Retinal fundus photograph; 1932x1916px — 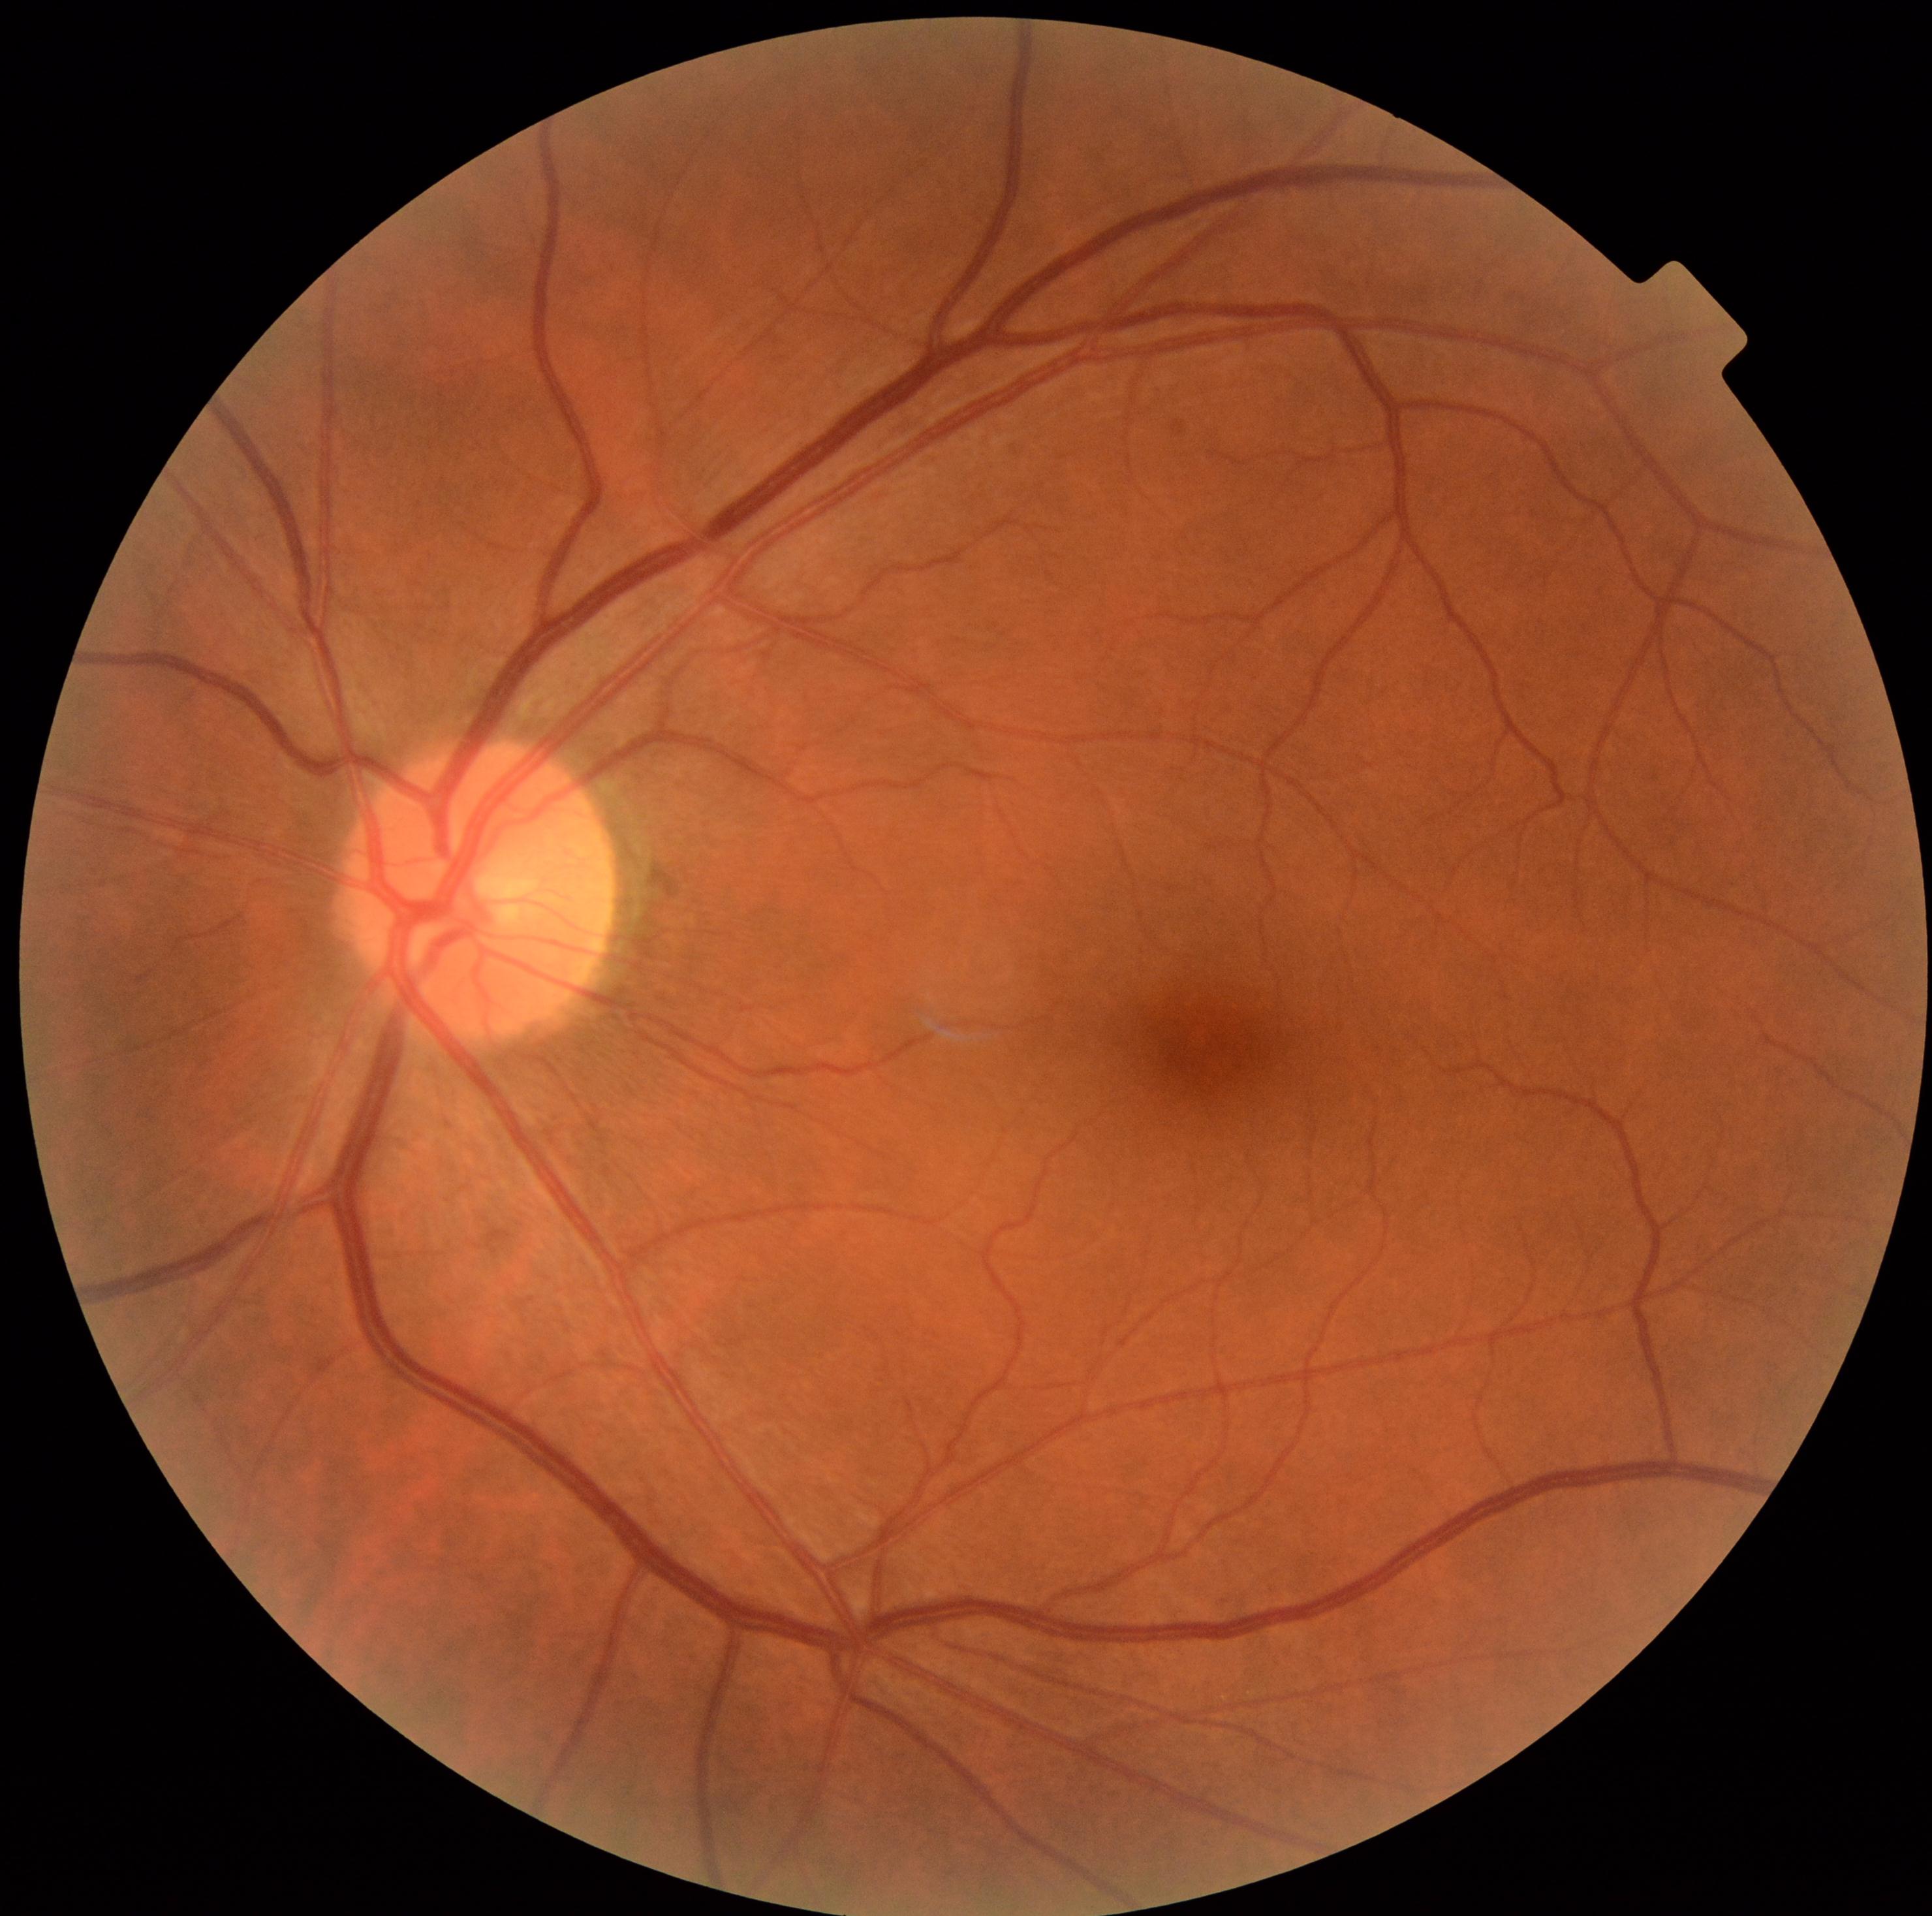
DR: 0/4.